848 x 848 pixels · 45-degree field of view · CFP · no pharmacologic dilation · camera: NIDEK AFC-230
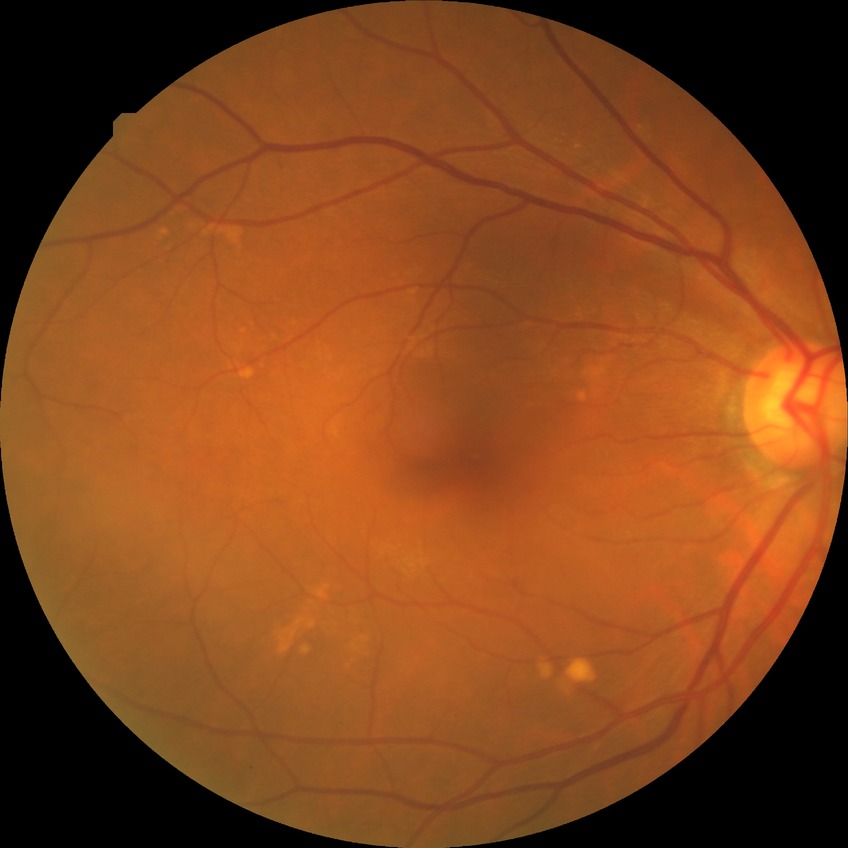
{"davis_grade": "NDR (no diabetic retinopathy)"}